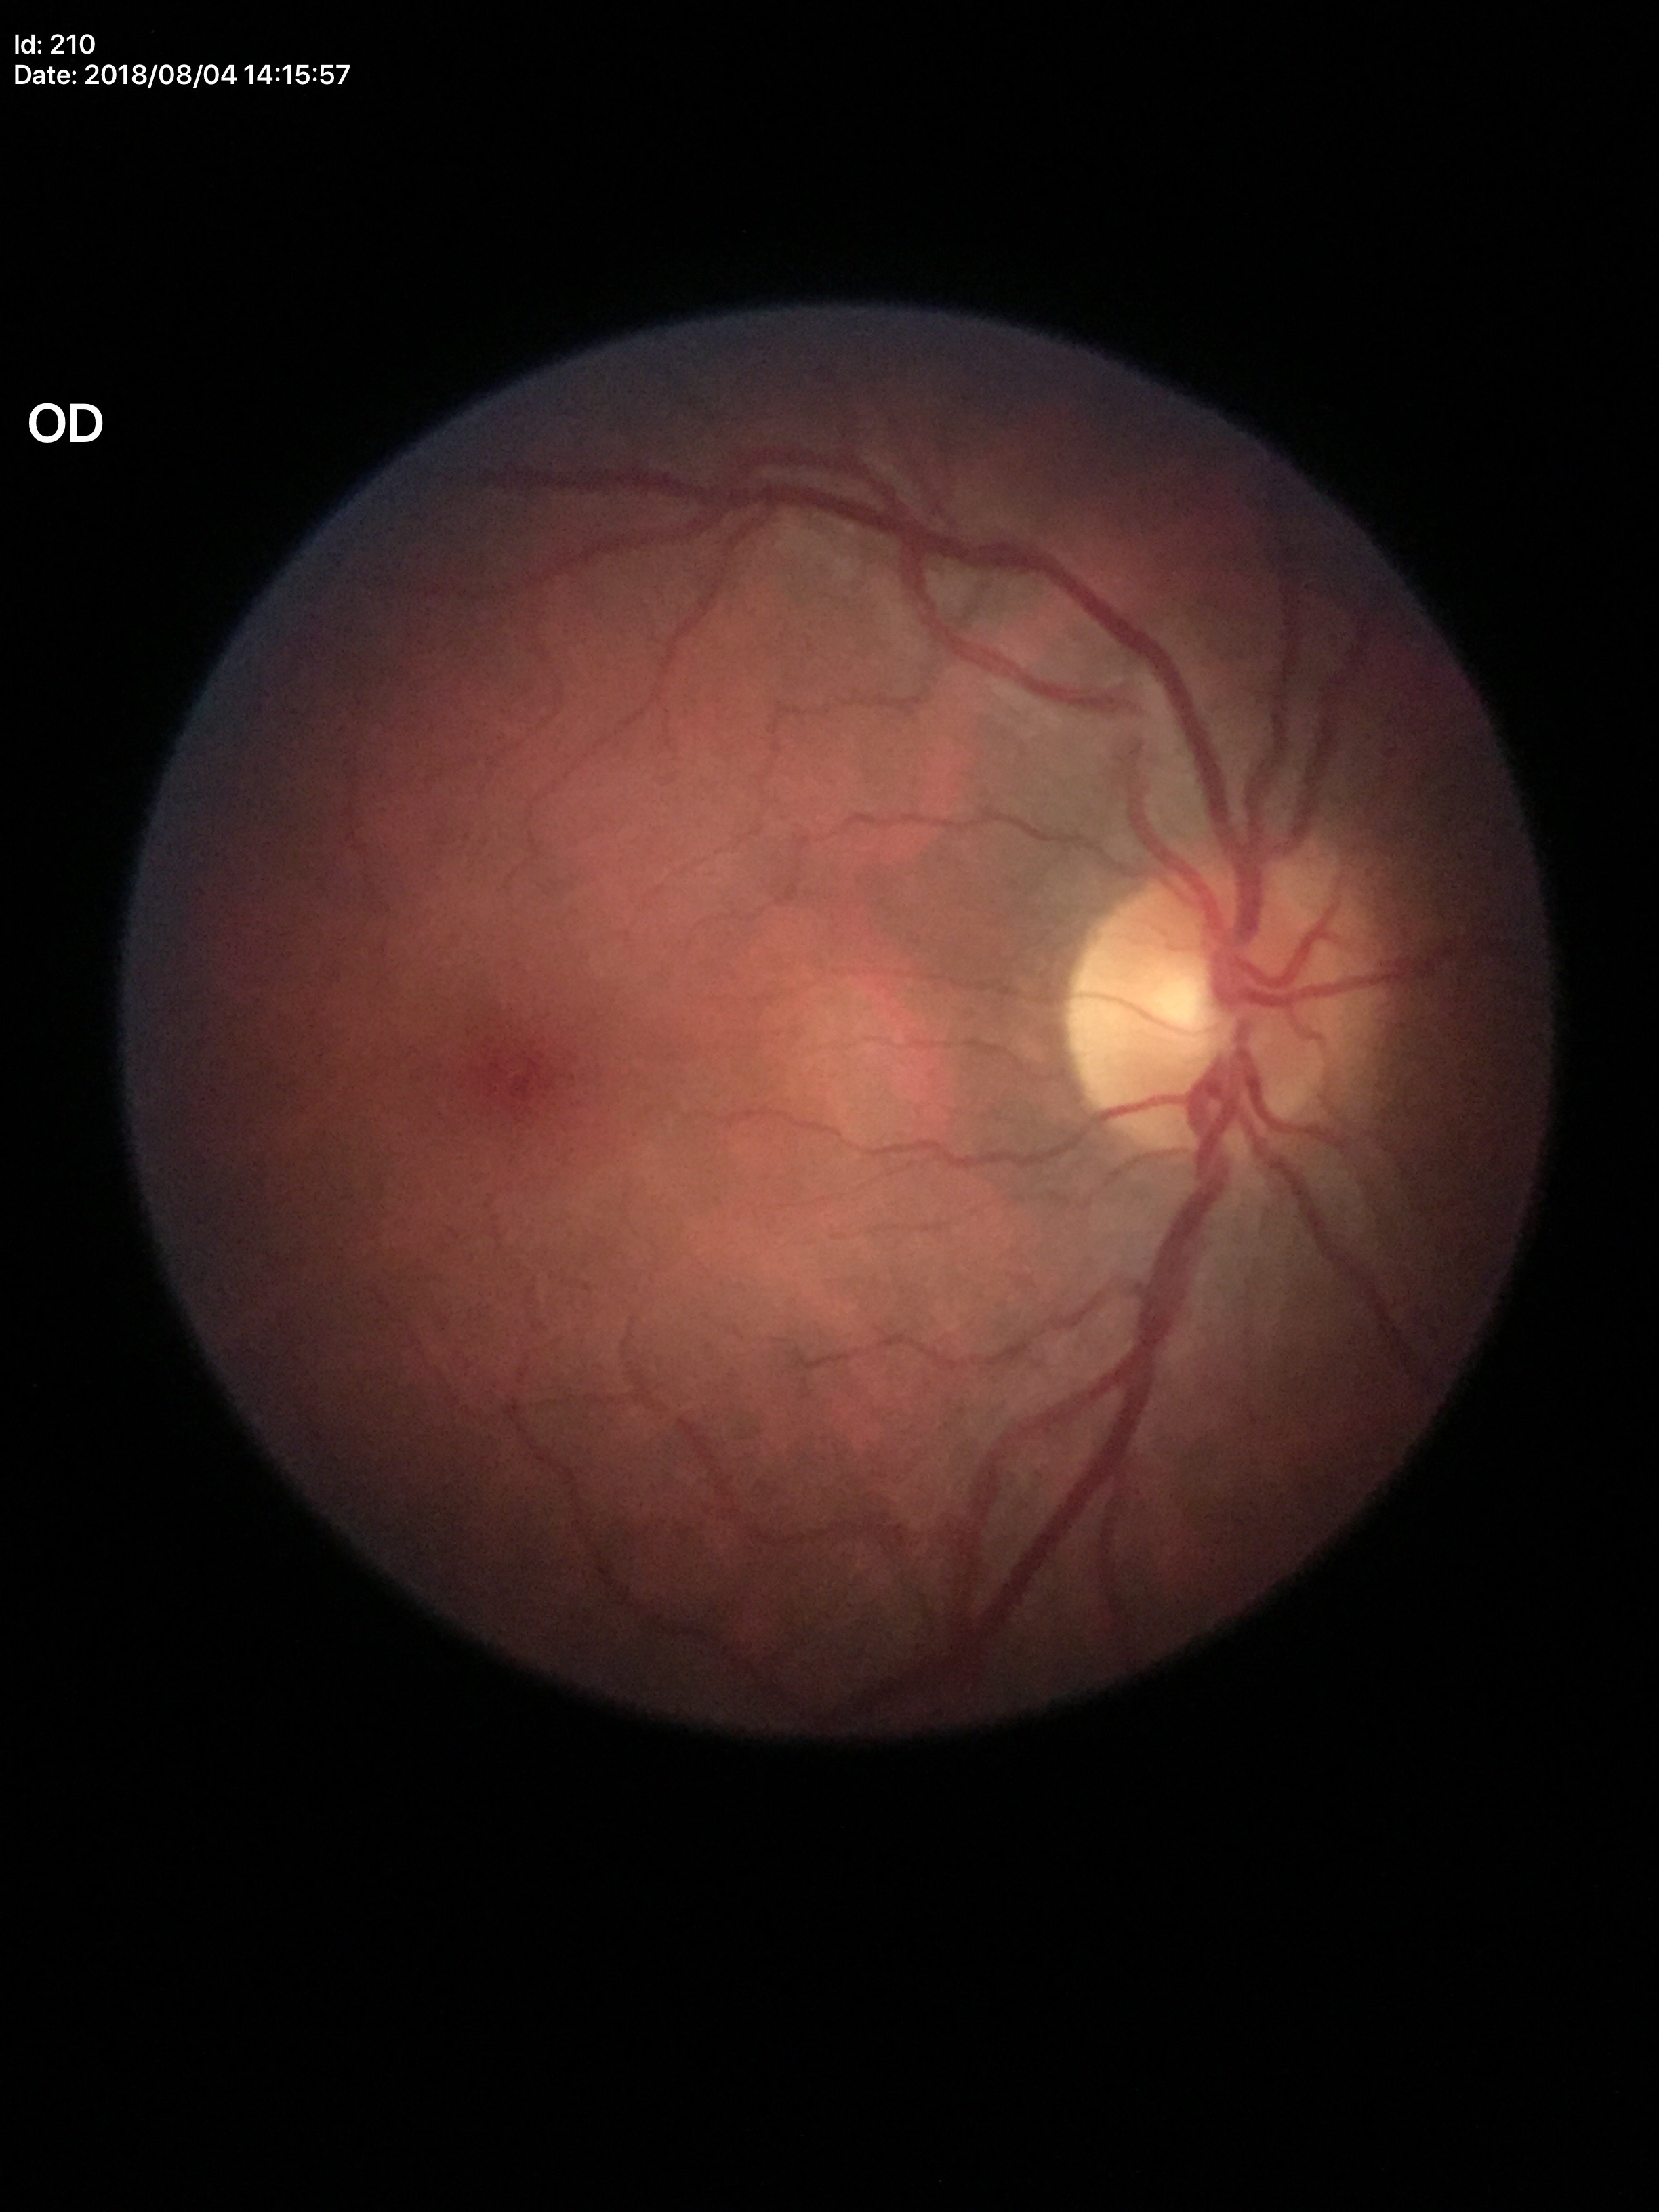 Glaucoma decision: no suspicious findings. VCDR: 0.53.